Clarity RetCam 3, 130° FOV. 640 by 480 pixels. Wide-field contact fundus photograph of an infant: 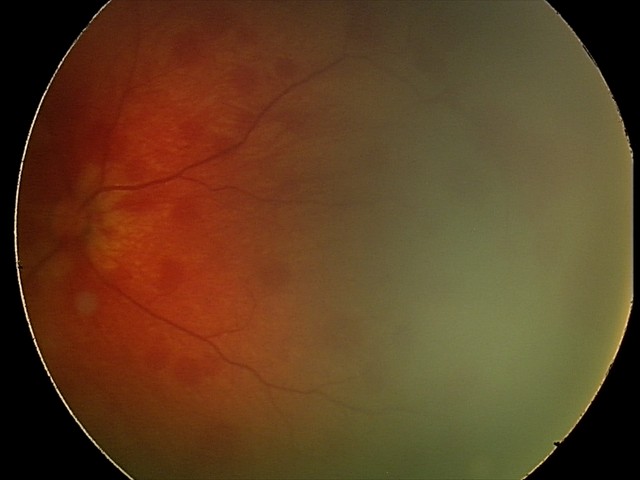 Examination diagnosed as retinal hemorrhages.